848 x 848 pixels · nonmydriatic · DR severity per modified Davis staging.
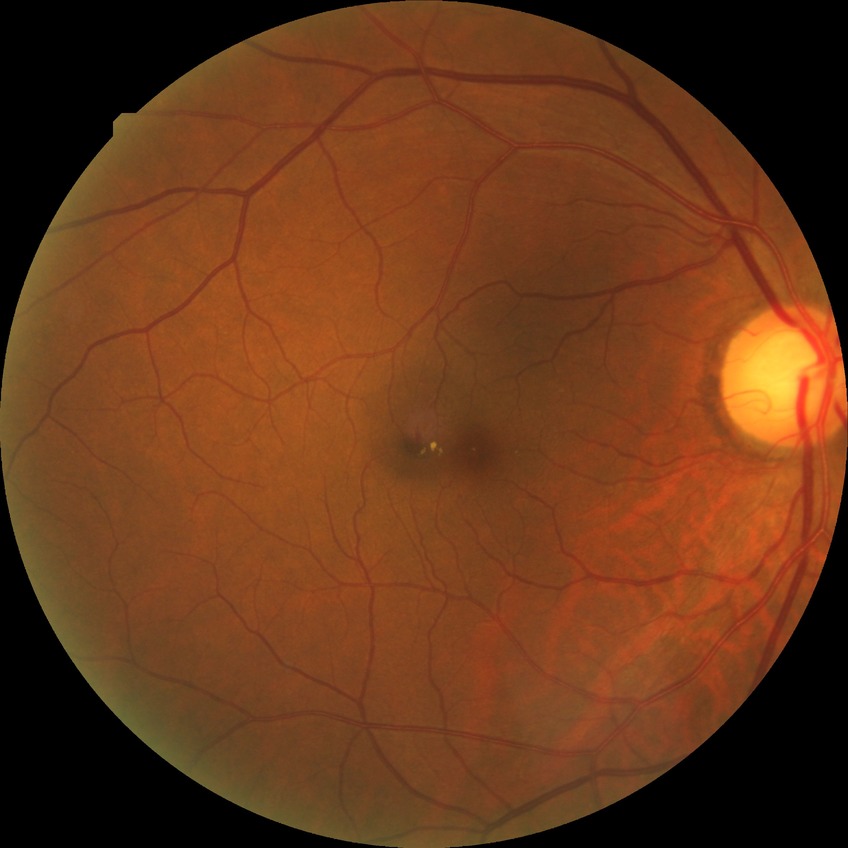 DR is SDR.